1659 by 2212 pixels: 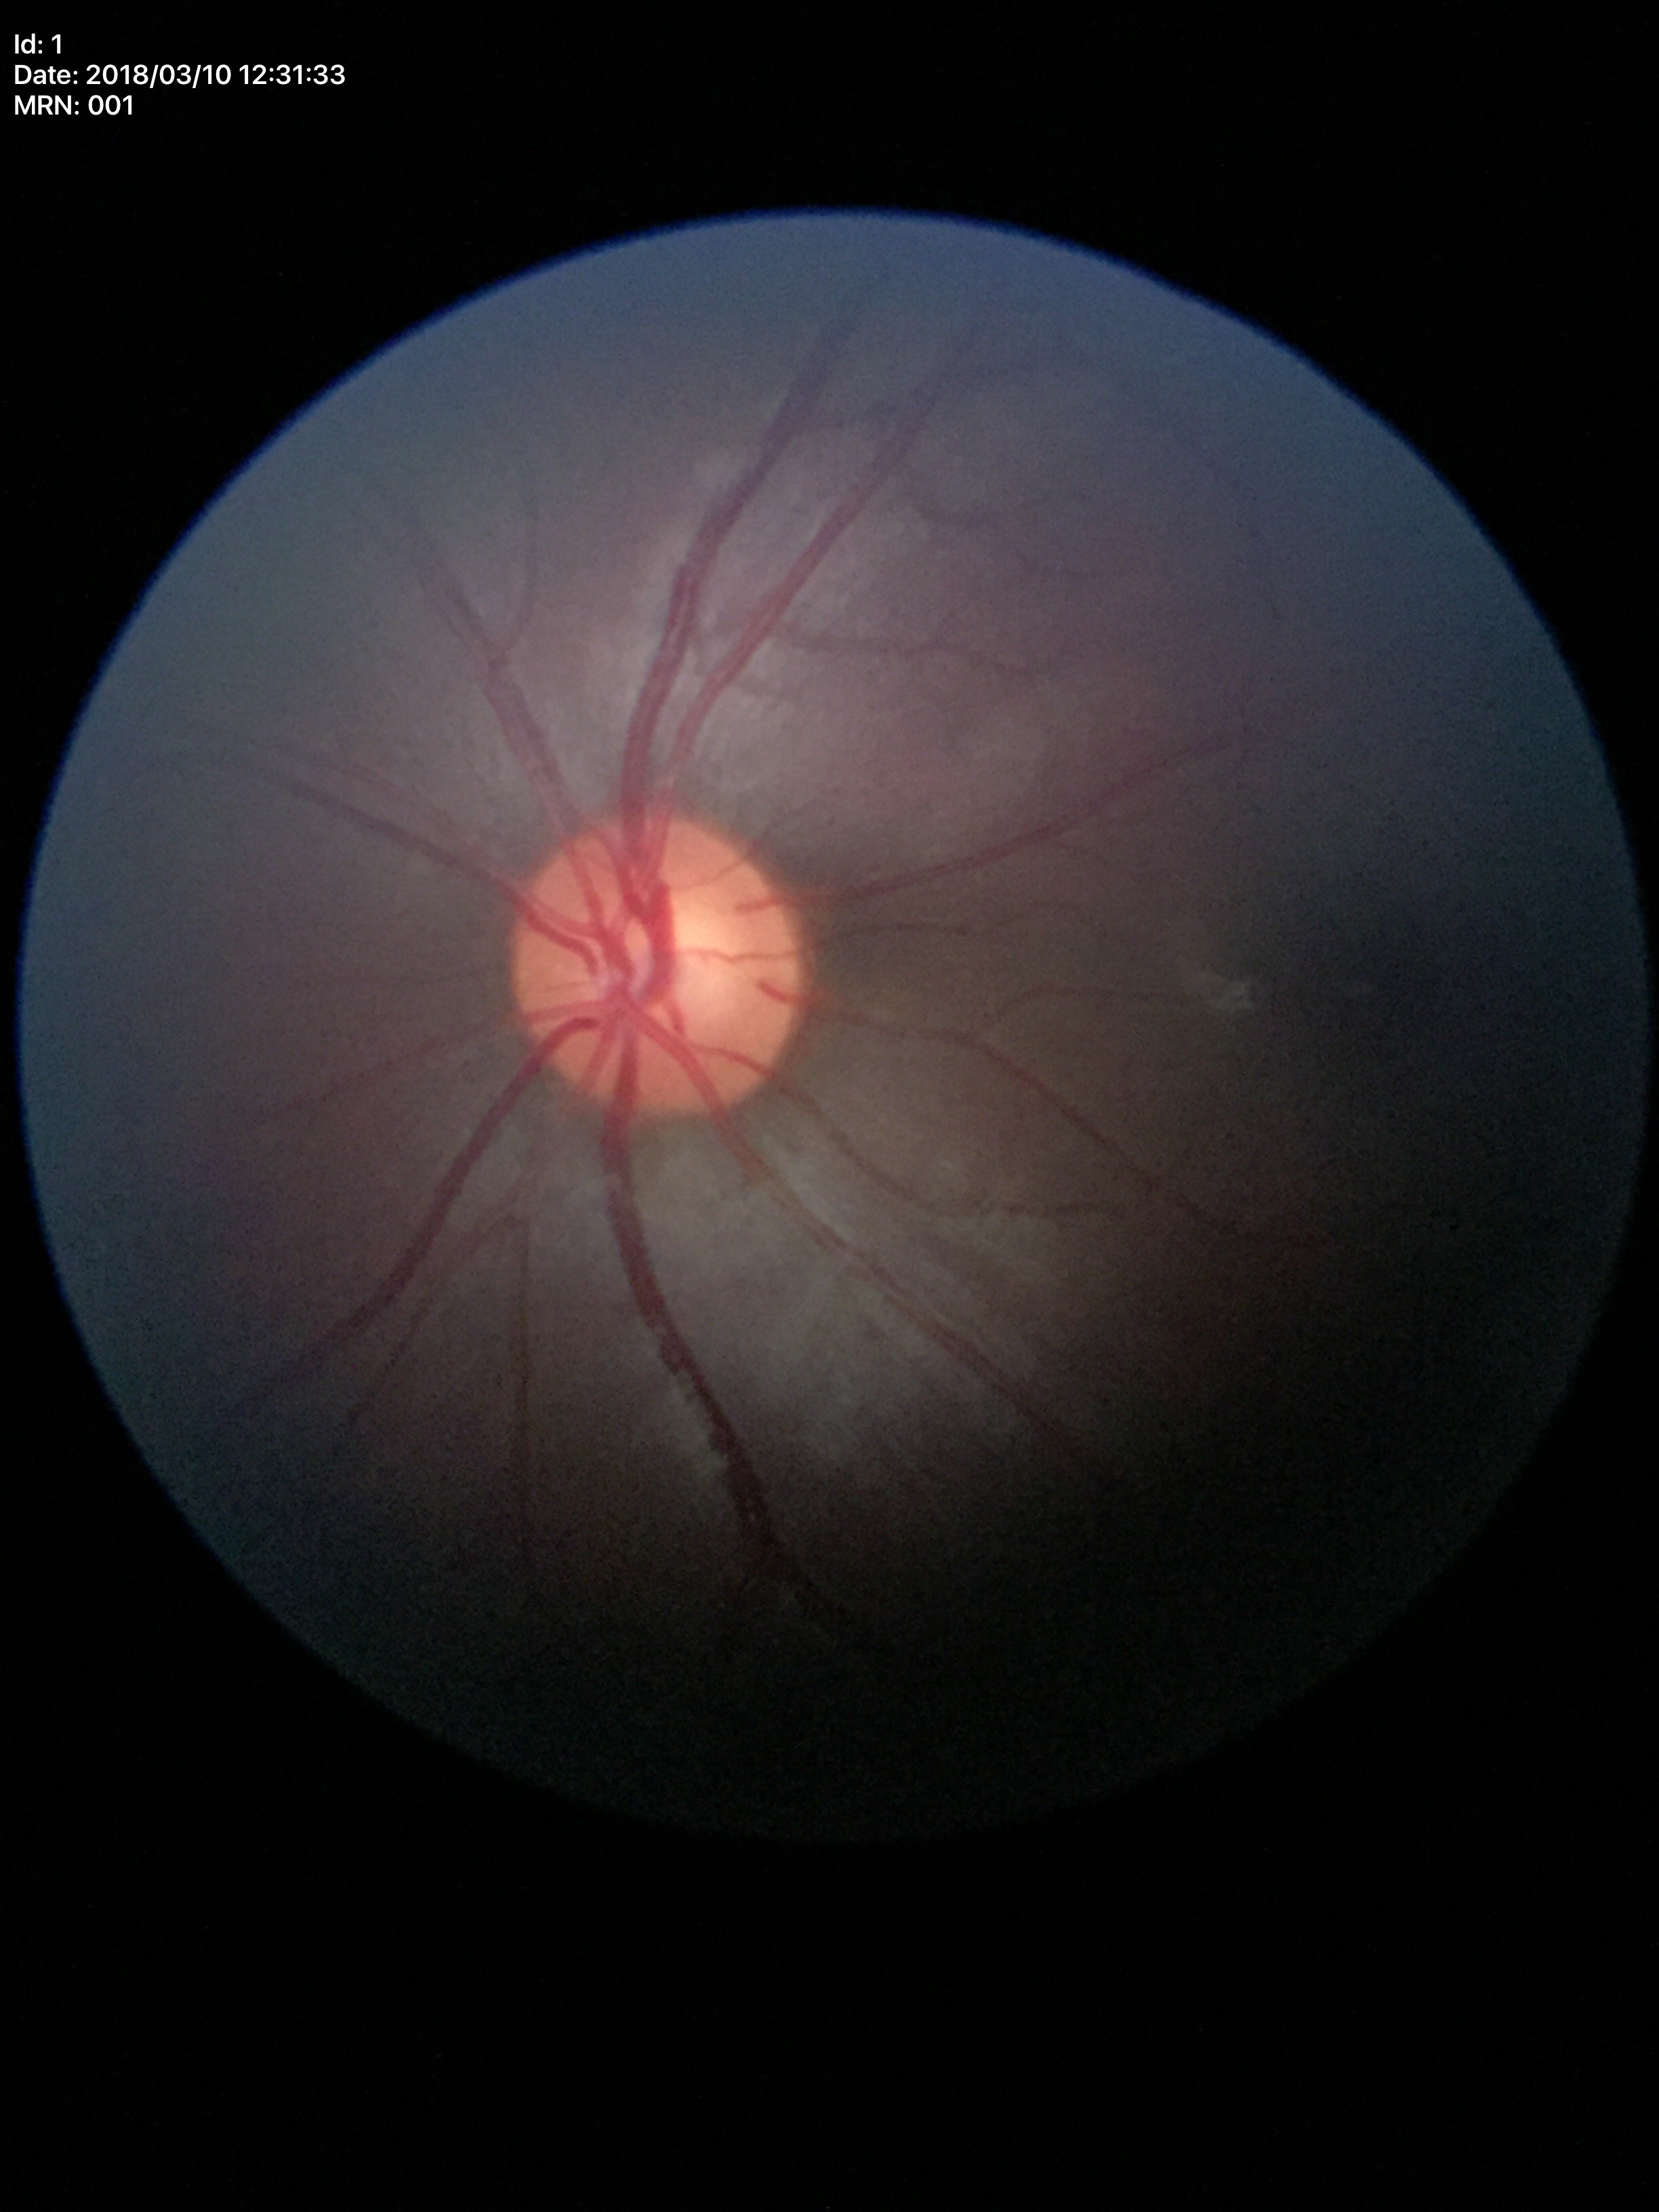

Glaucoma impression: negative.
Vertical C/D ratio of 0.54.